No pharmacologic dilation · NIDEK AFC-230 · fundus photo: 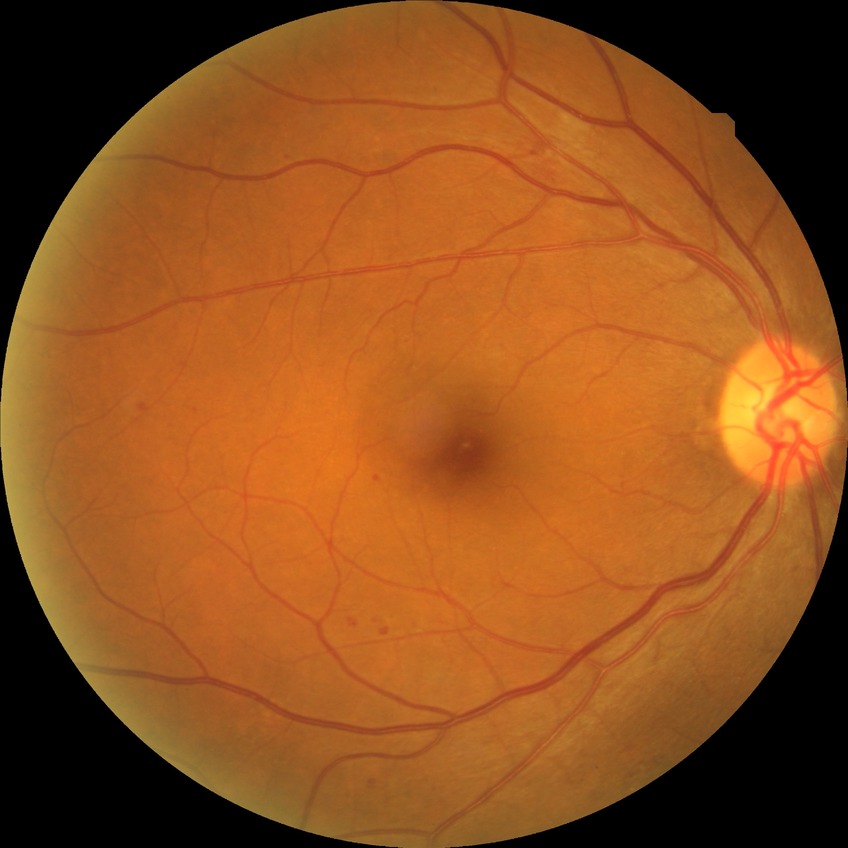 Annotations:
• DR severity — SDR